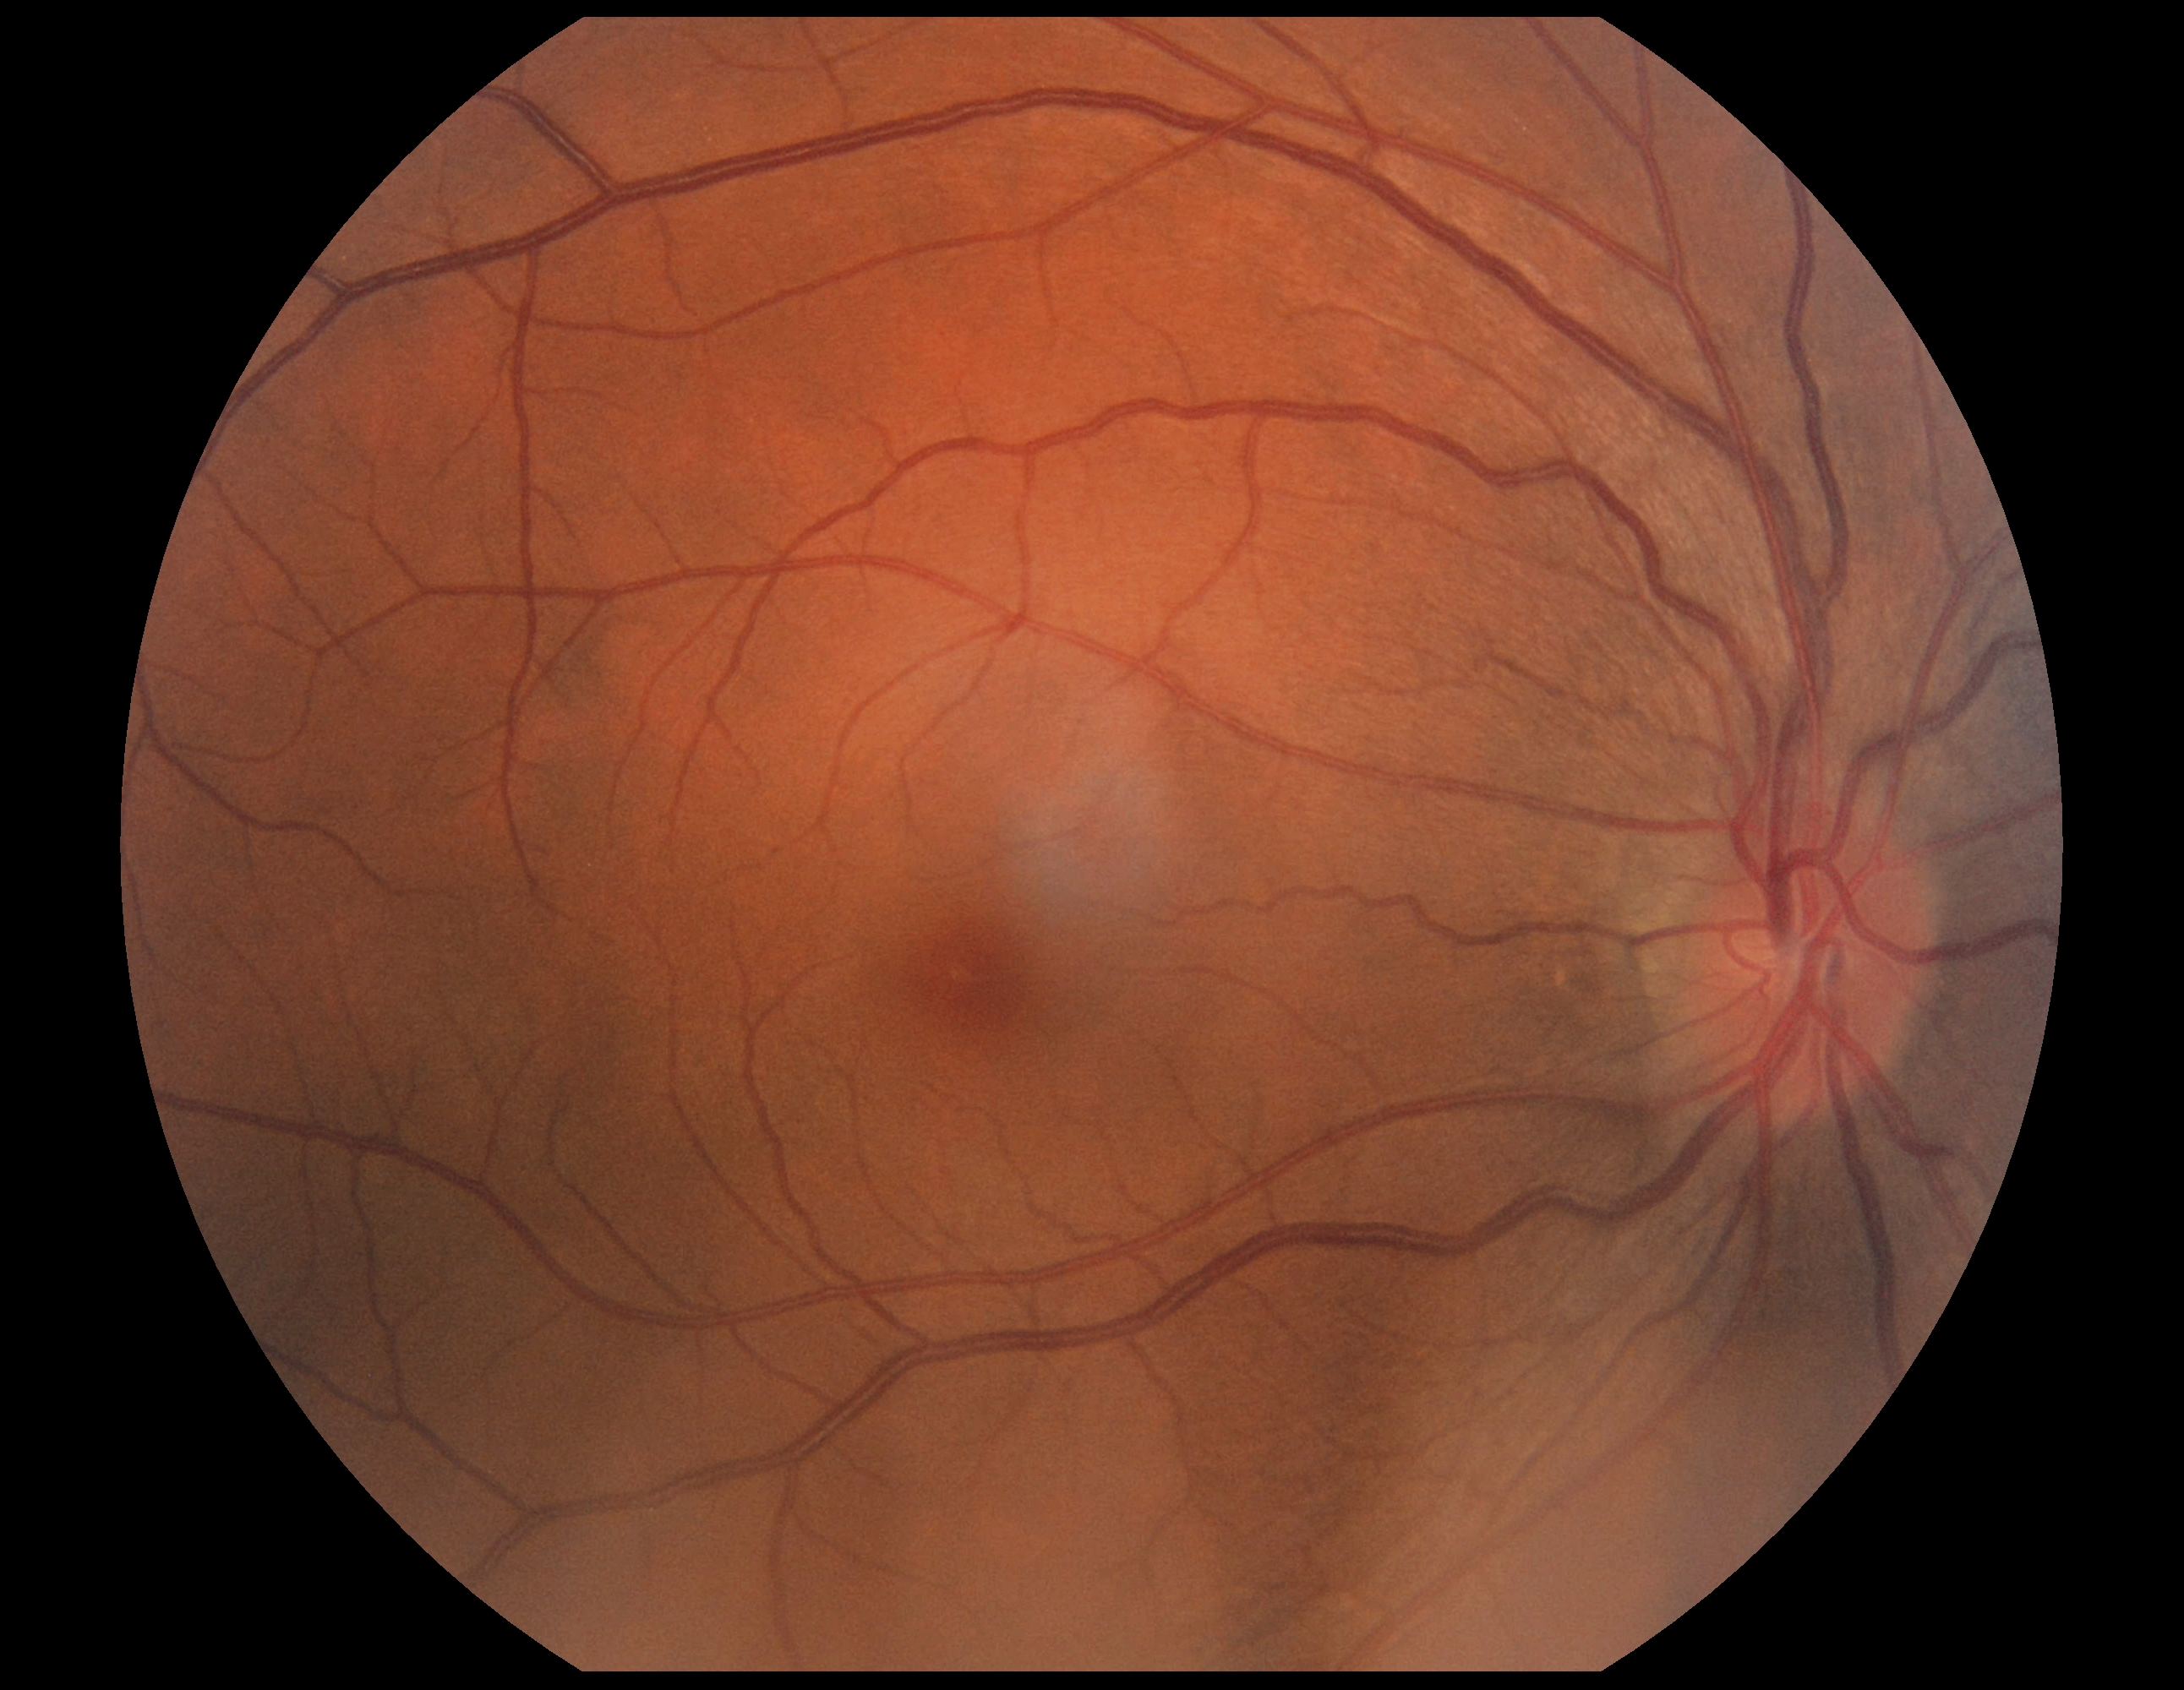

DR grade = 0 (no apparent retinopathy)